FOV: 45 degrees, color fundus image, 2352x1568px.
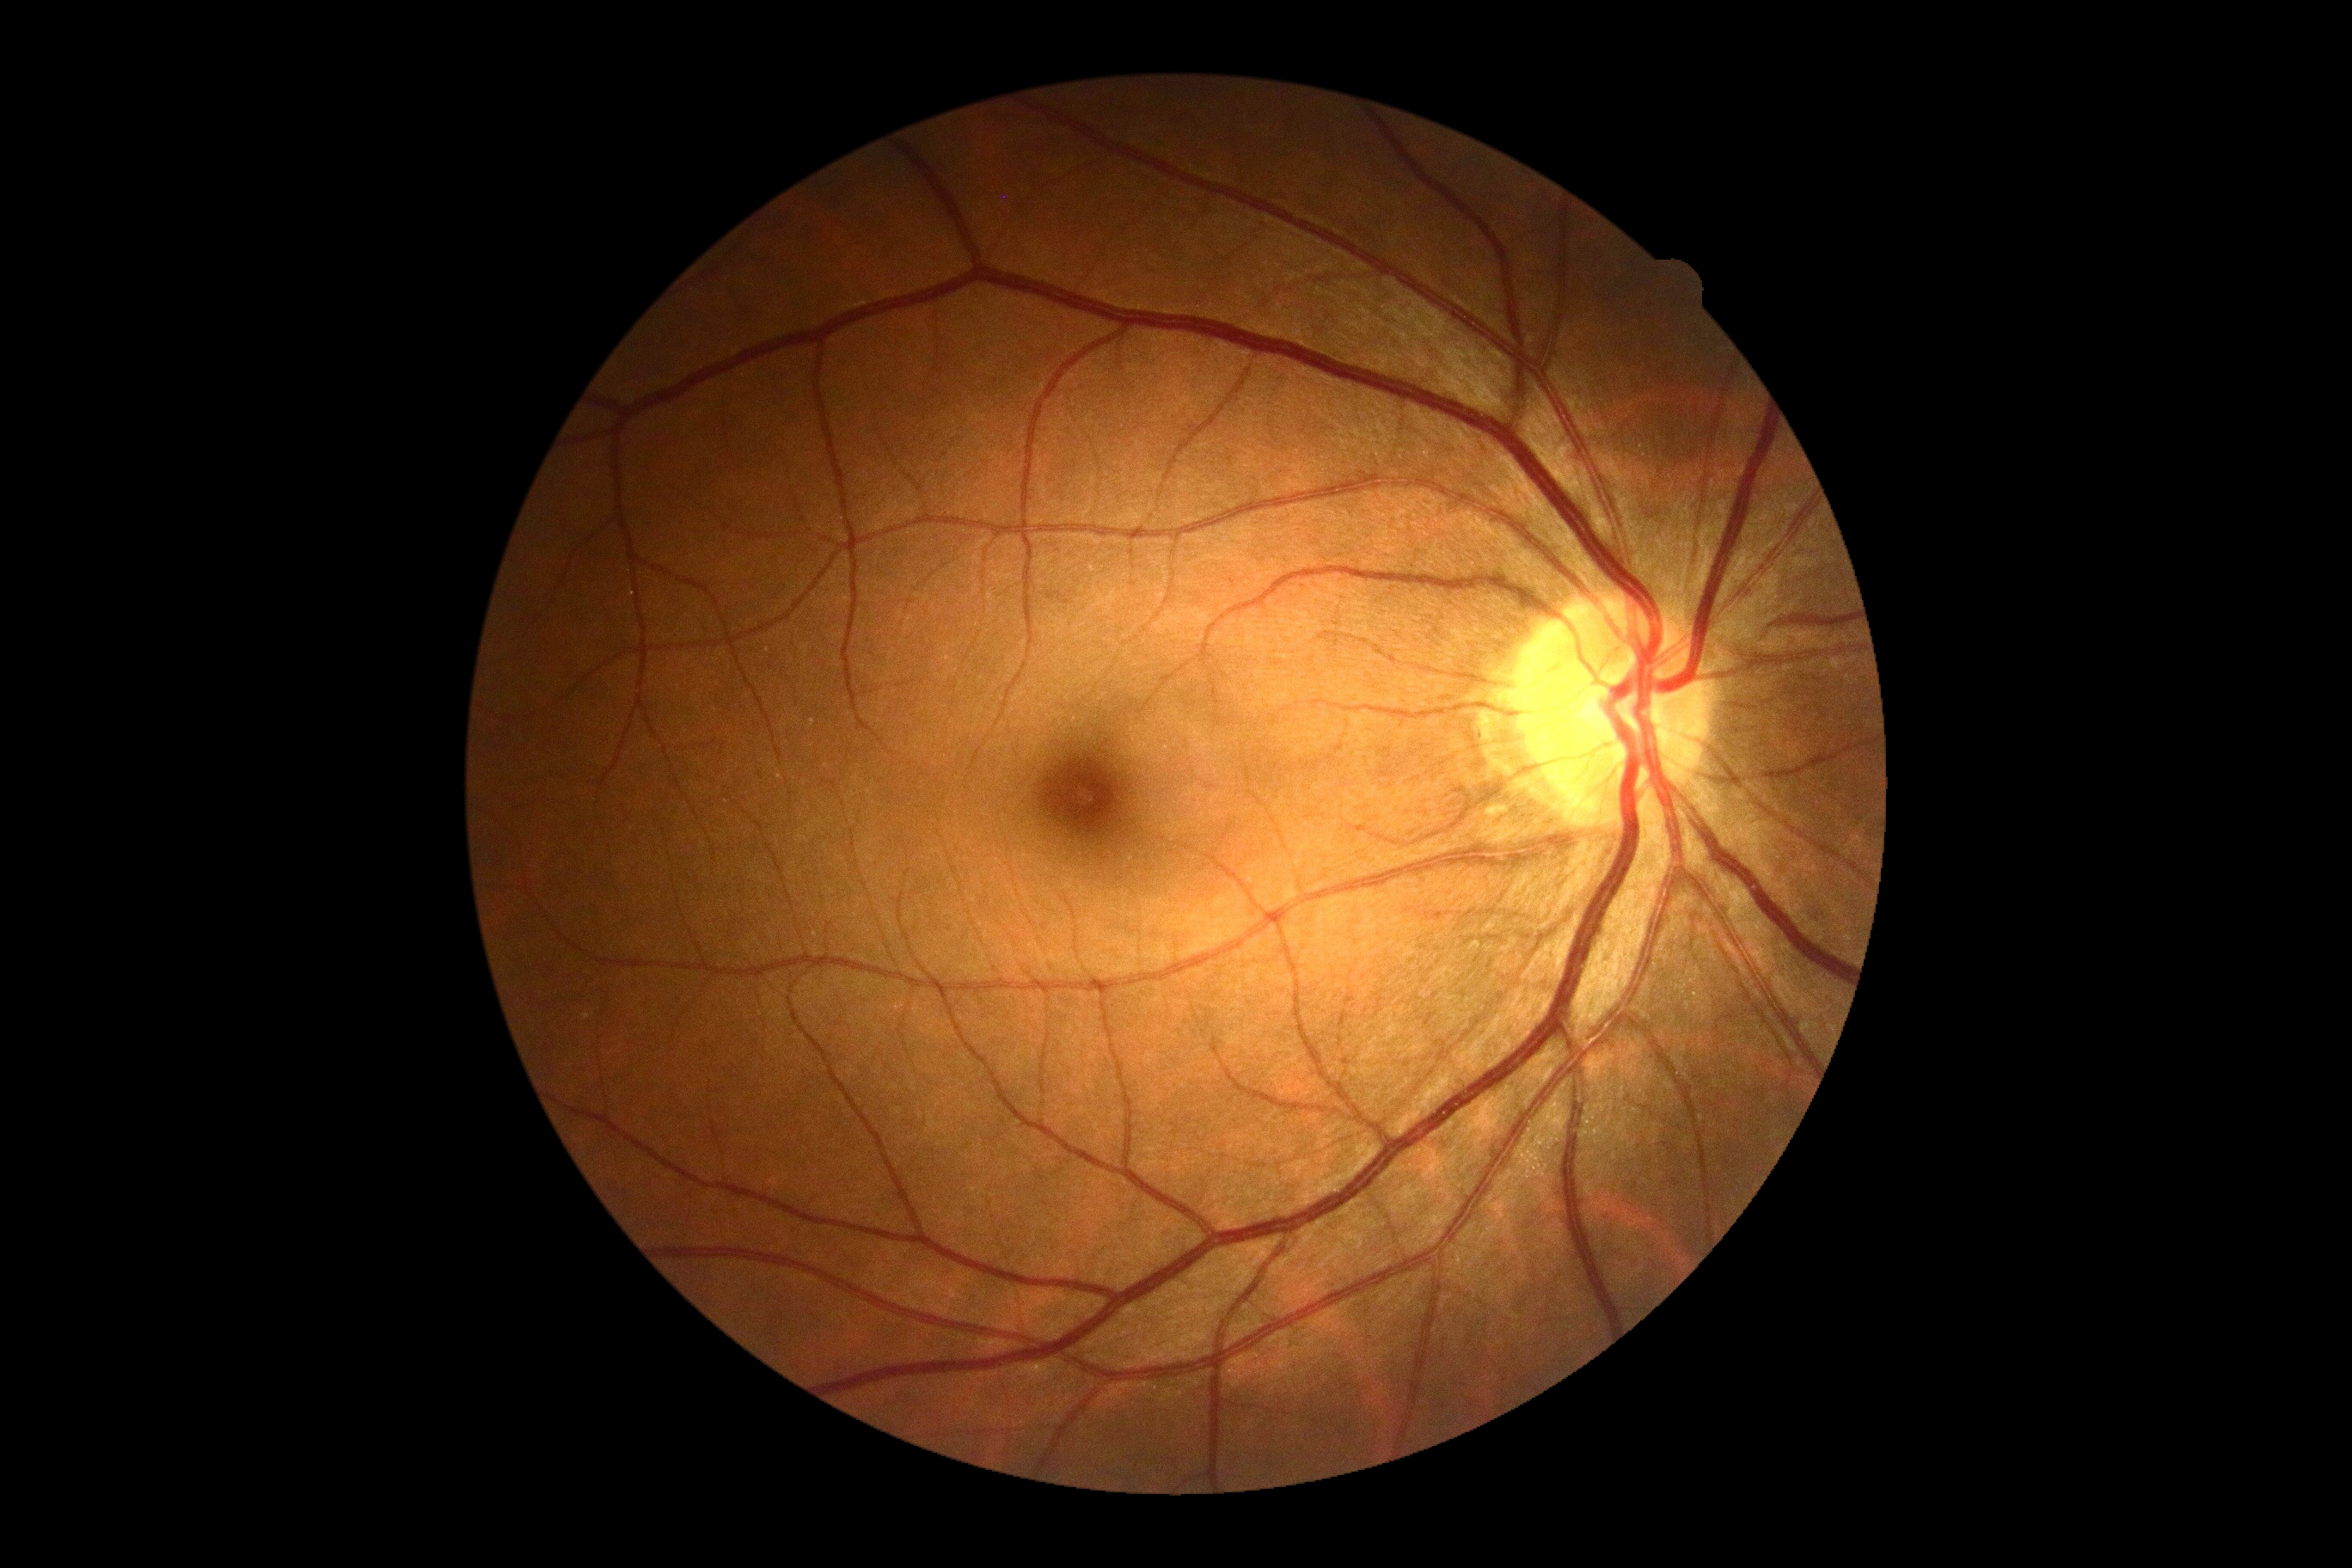

DR grade is no apparent retinopathy (0).